1536x1152: 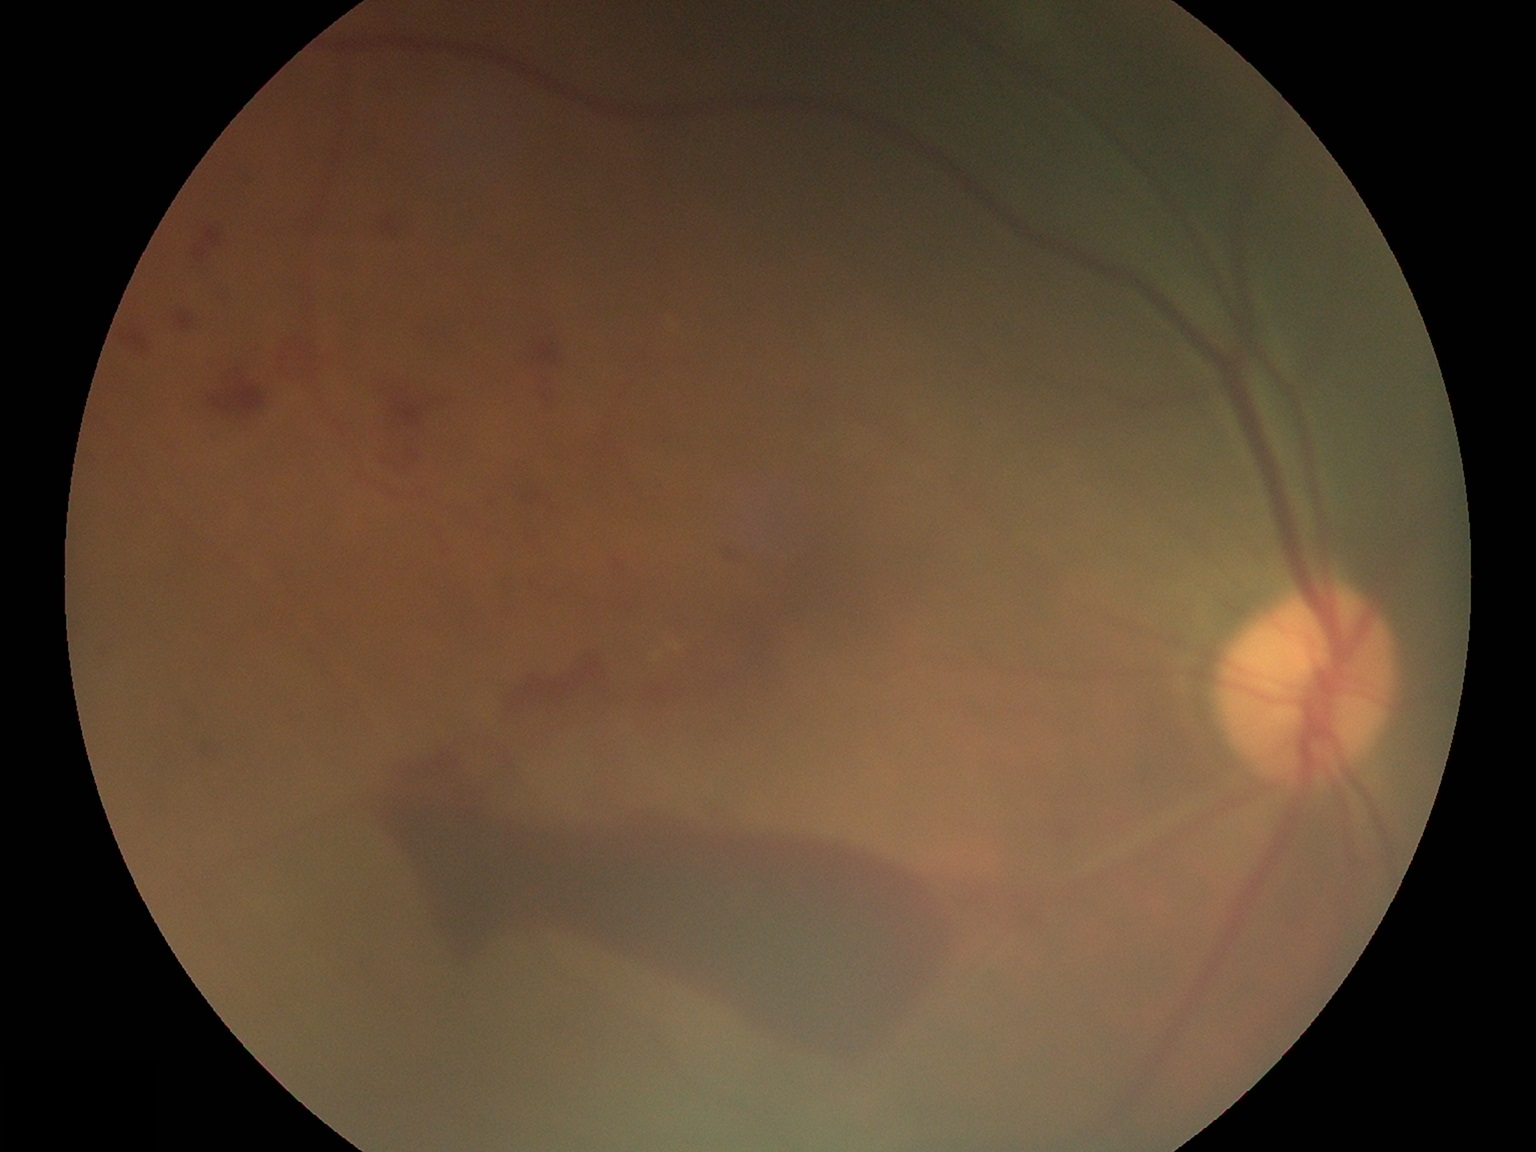

Diabetic retinopathy (DR) is grade 4 (PDR). DR class: proliferative diabetic retinopathy.